Color fundus photograph
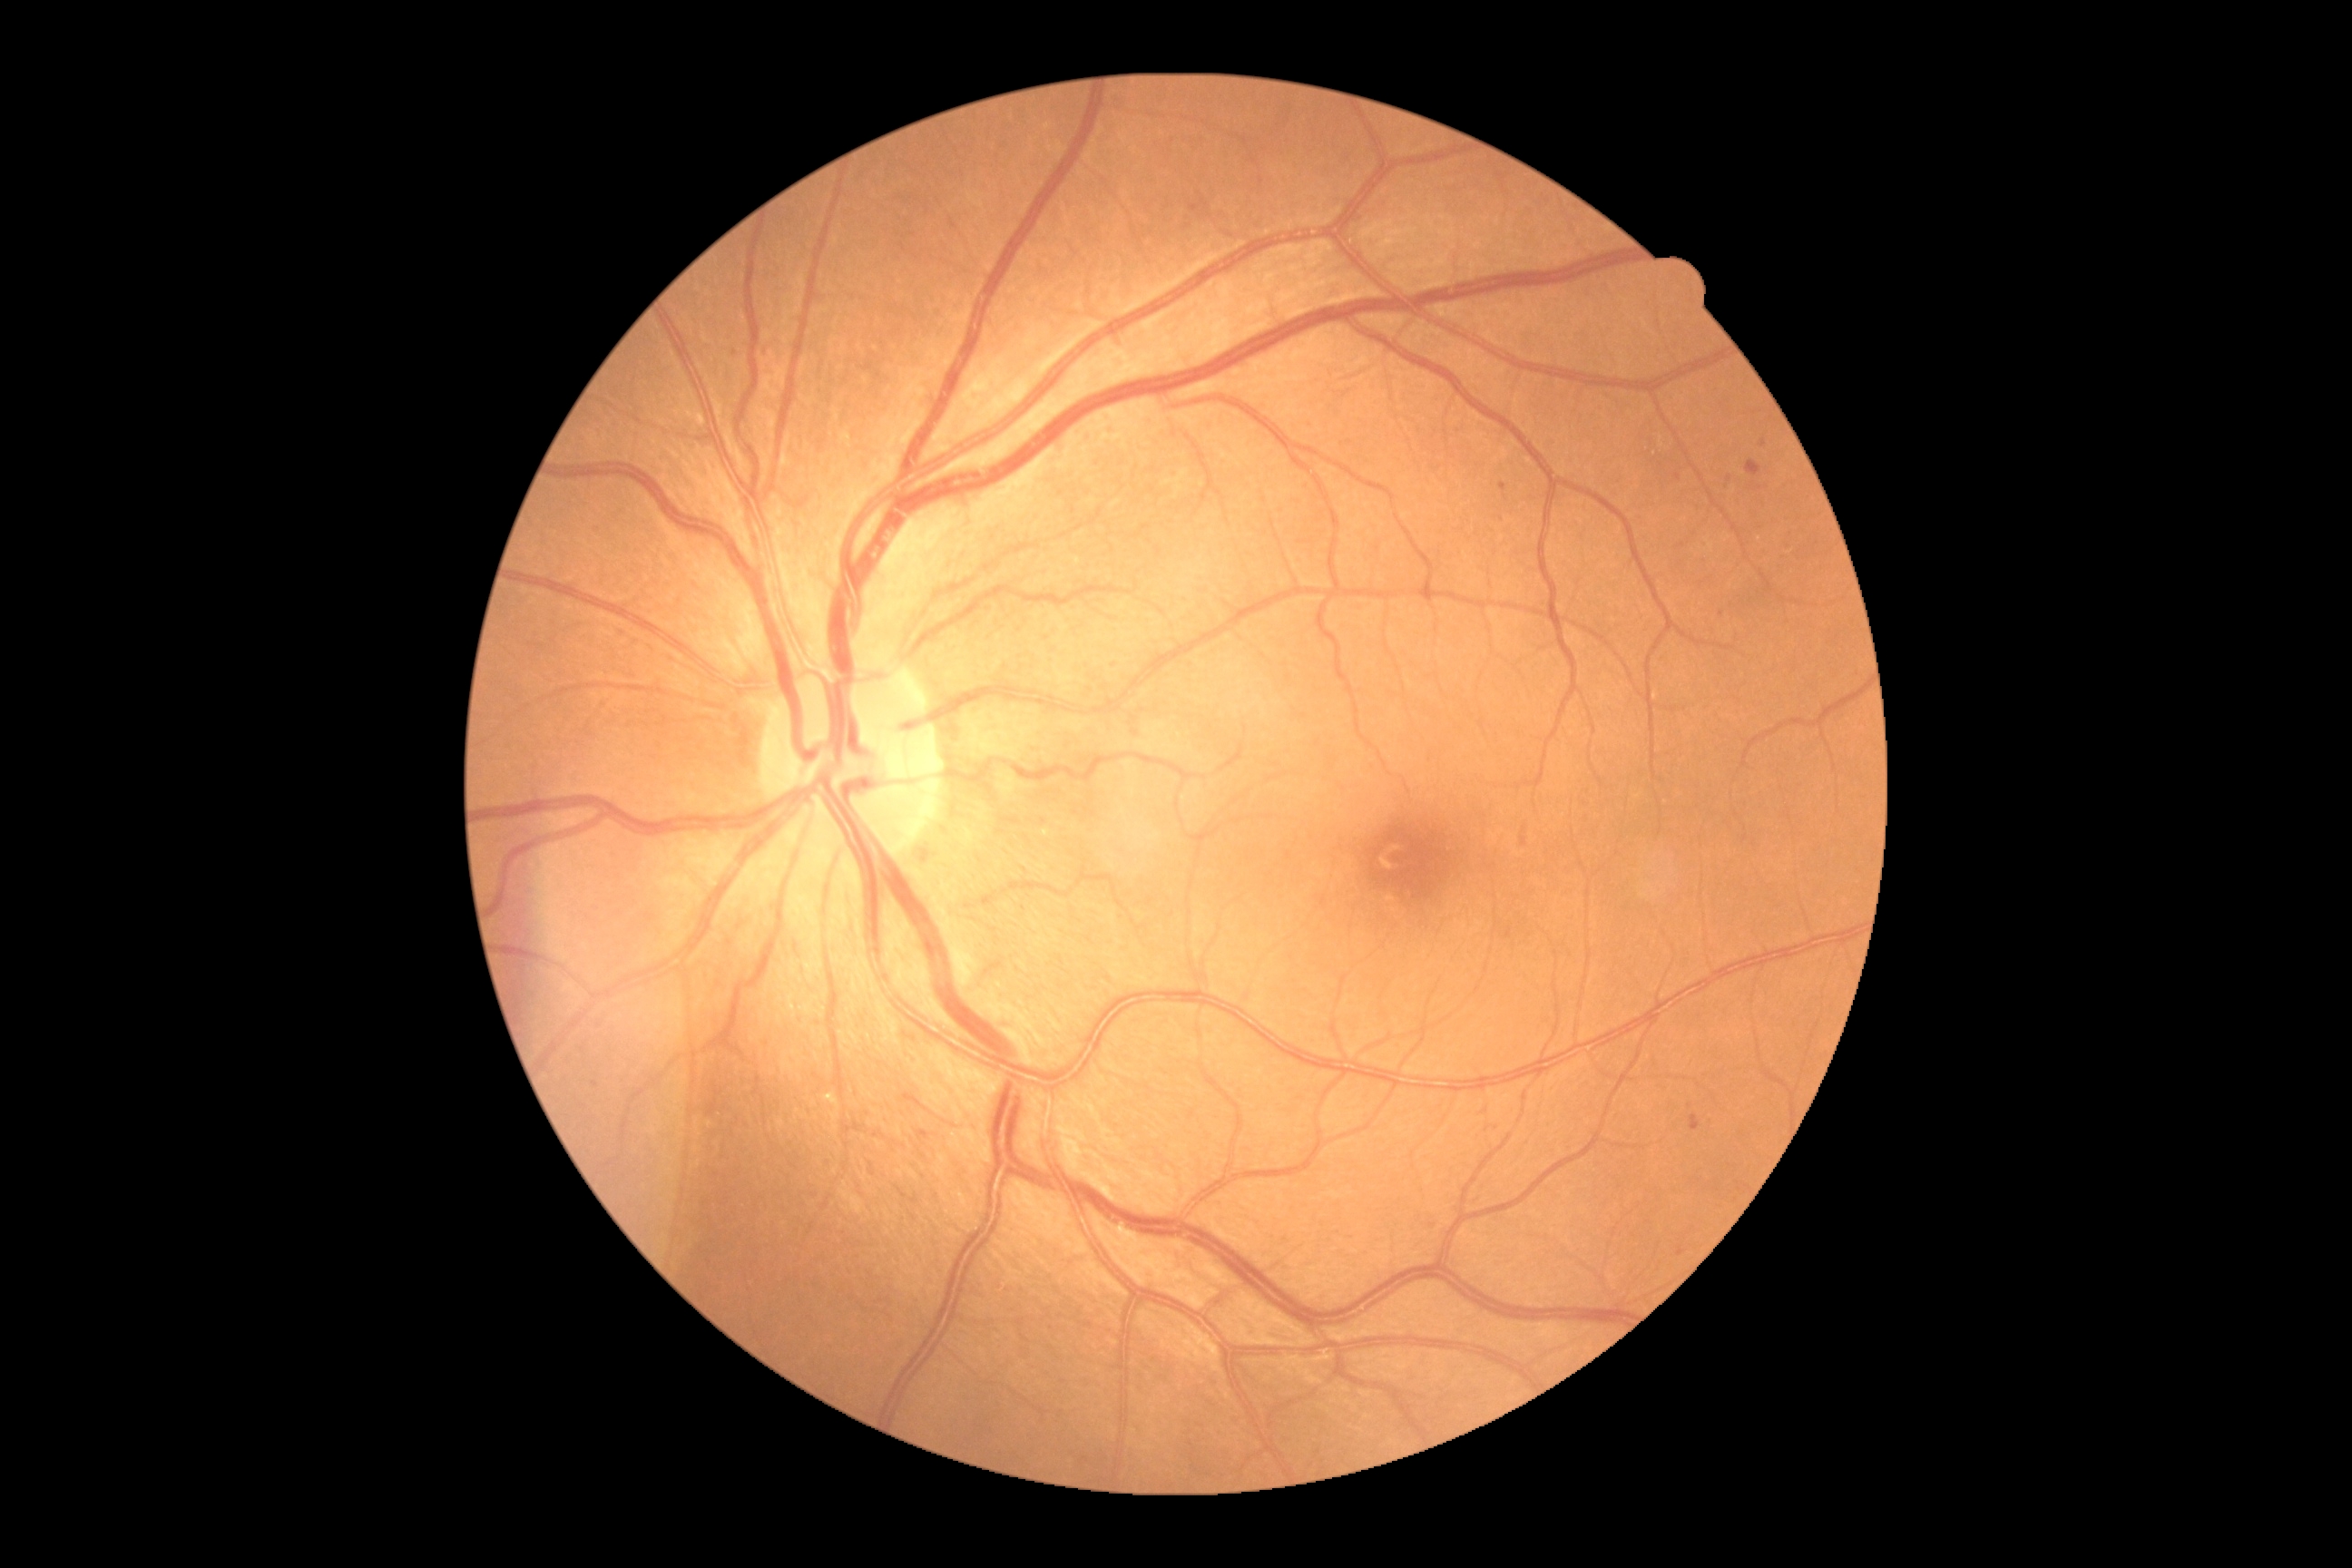

Annotations:
* DR class — non-proliferative diabetic retinopathy
* retinopathy — grade 2 (moderate NPDR)